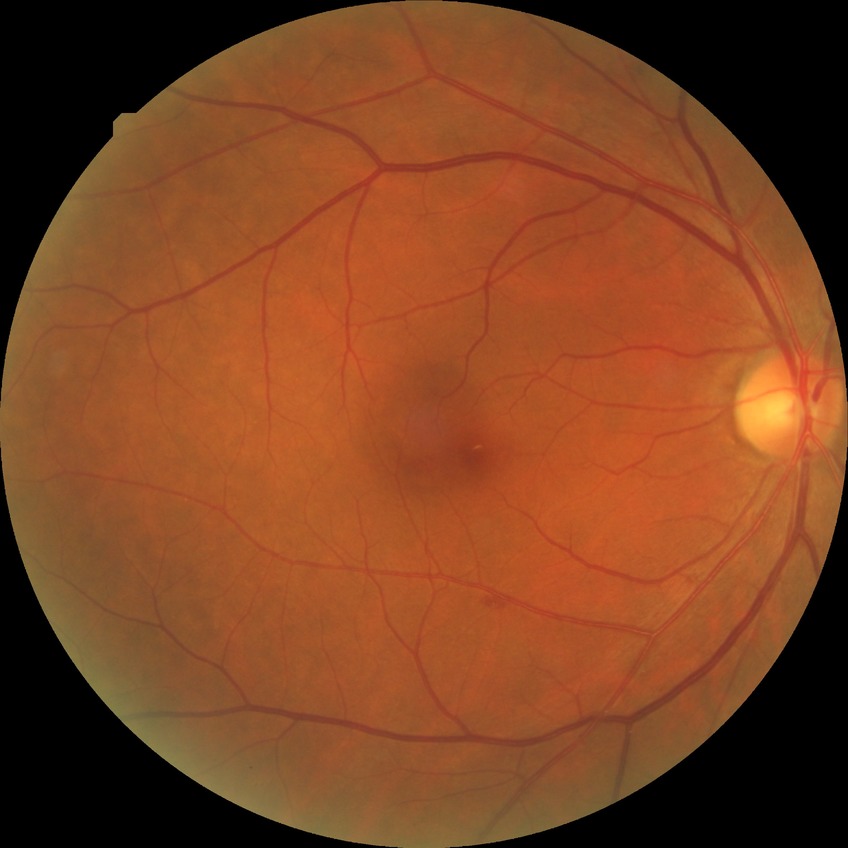 diabetic retinopathy (DR)=SDR (simple diabetic retinopathy).